45° field of view:
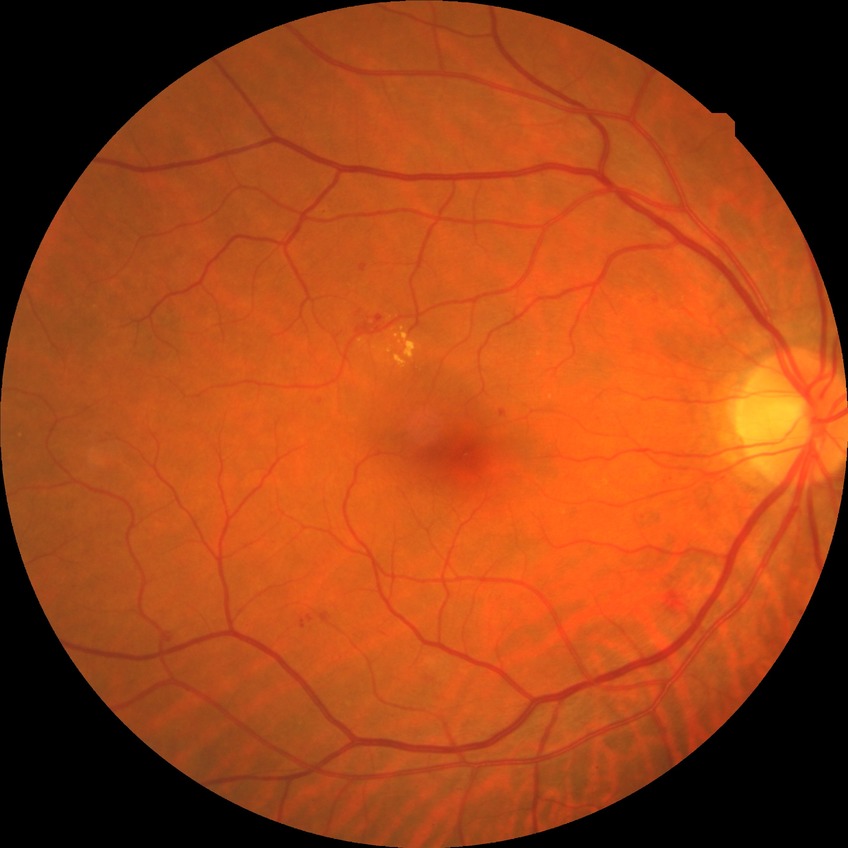

  davis_grade: SDR (simple diabetic retinopathy)